CFP
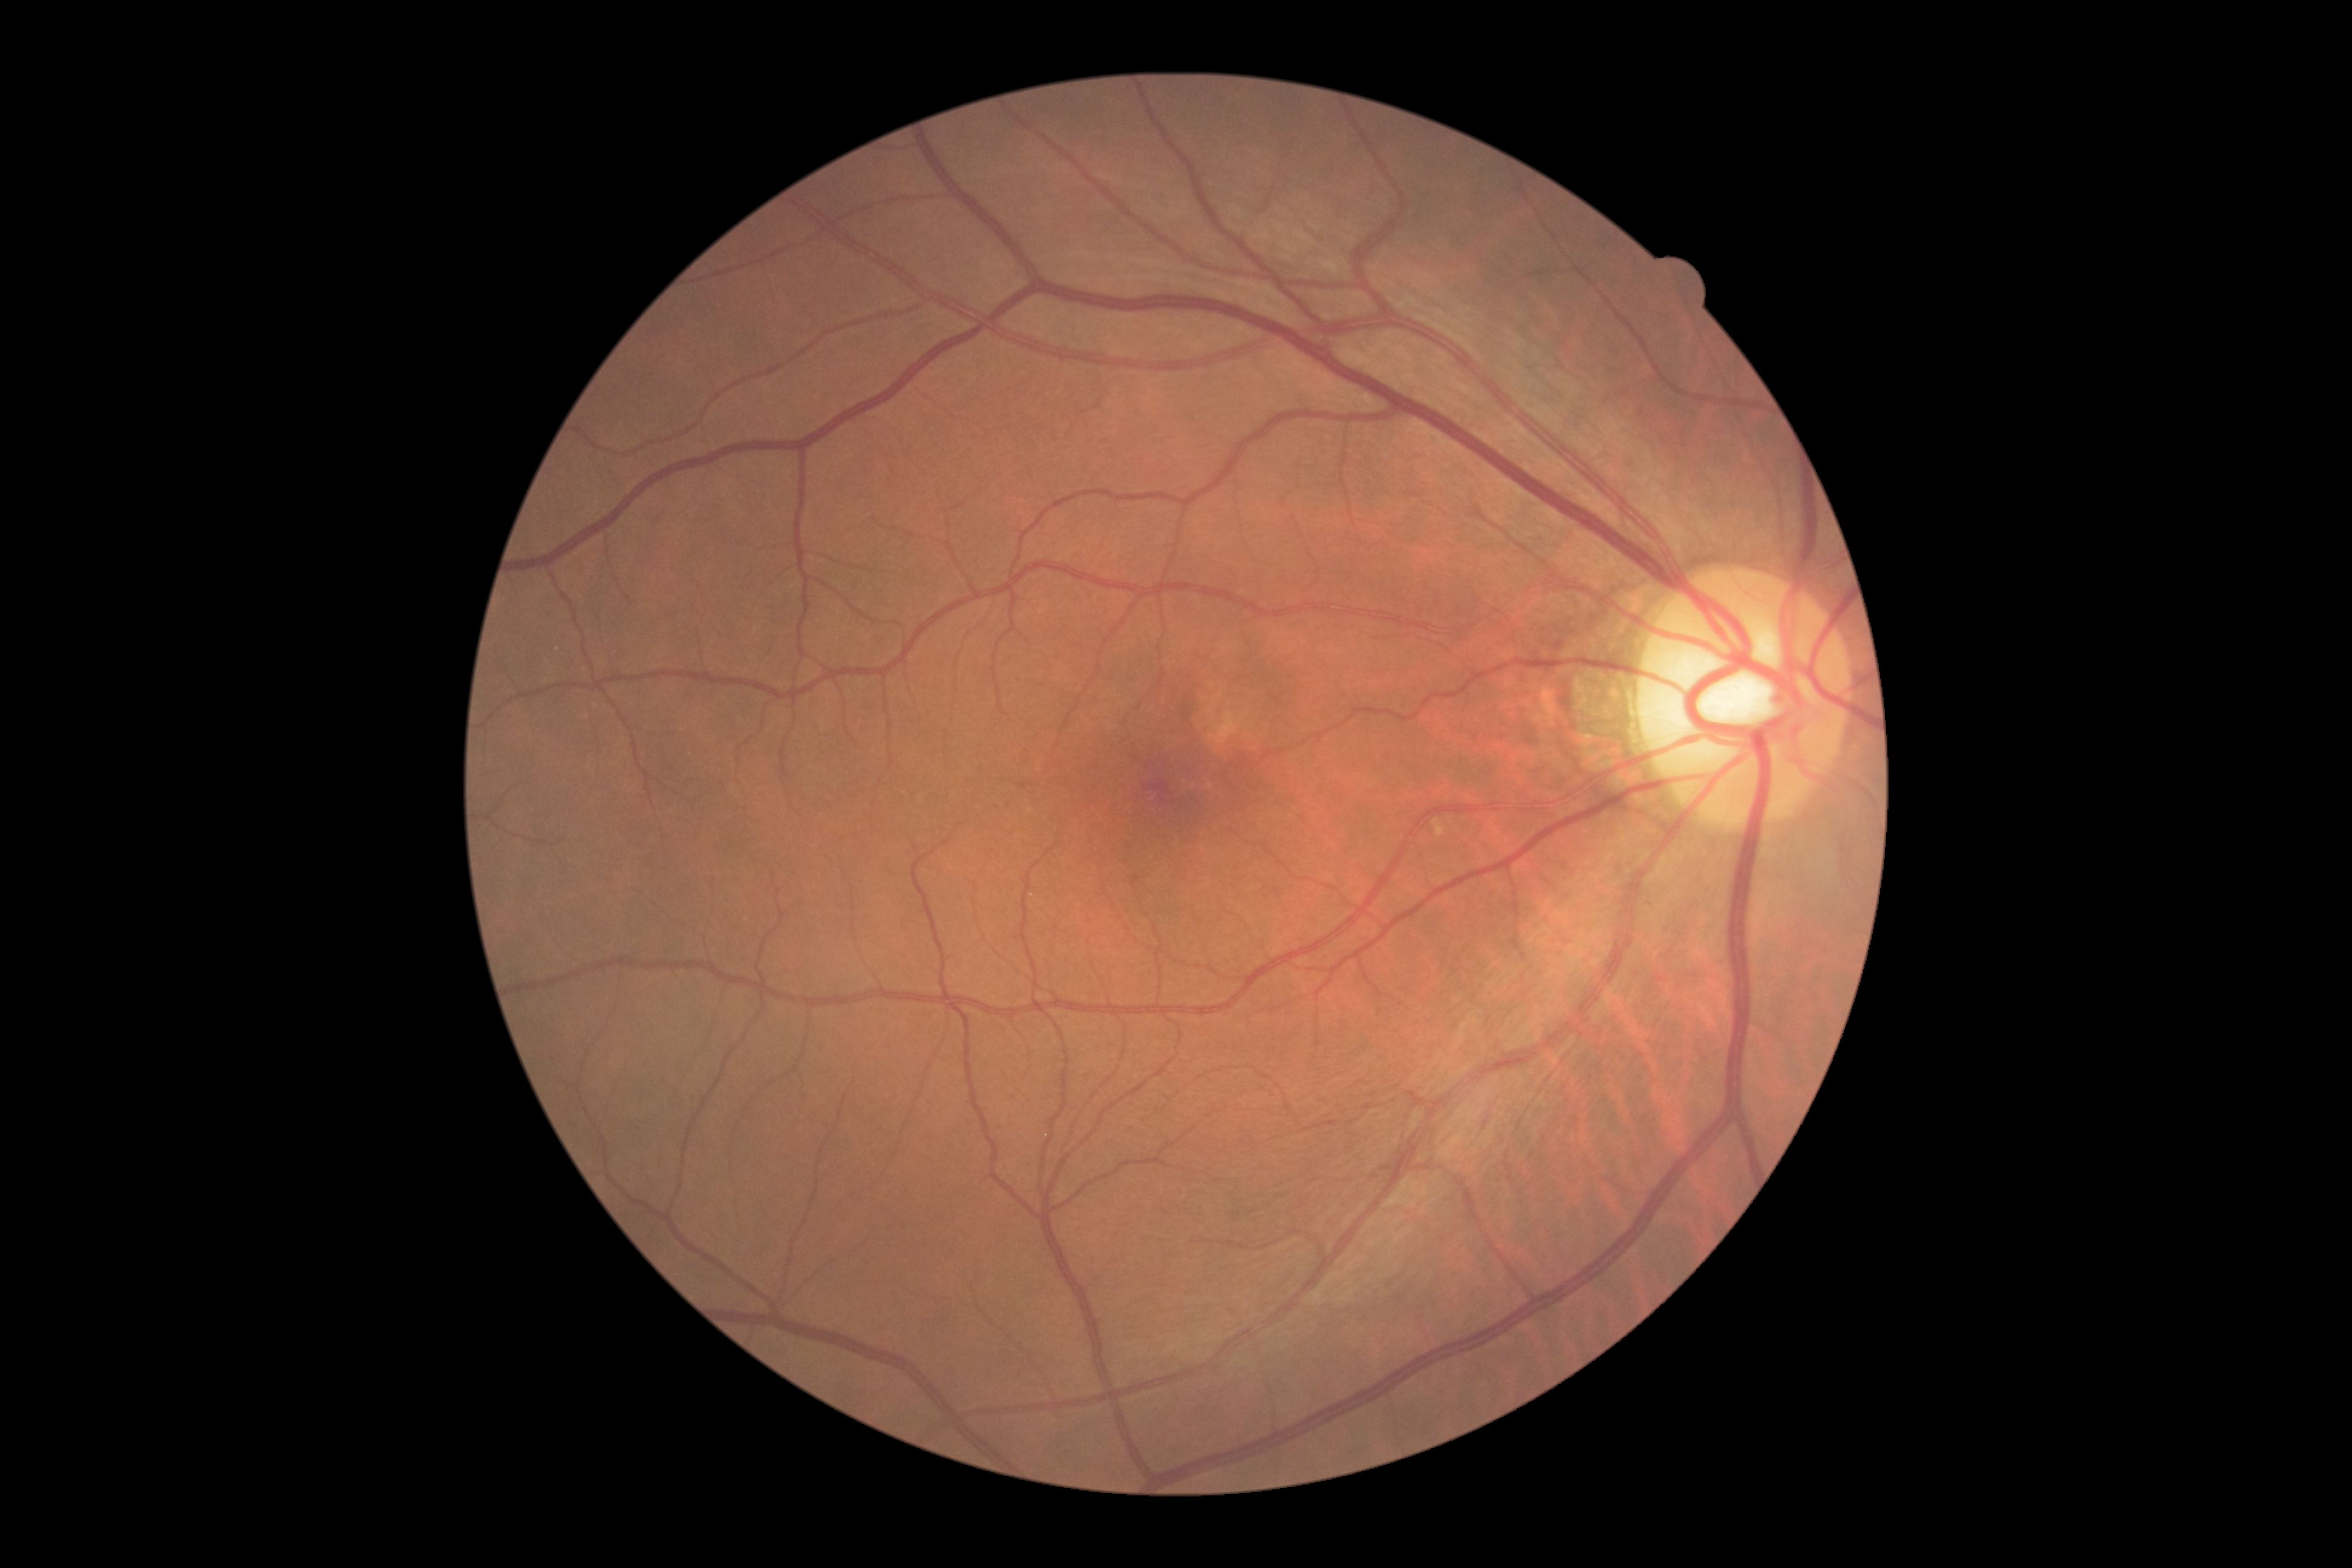

• diabetic retinopathy severity: no apparent retinopathy (grade 0)
• DR impression: no signs of DR